848x848px · FOV: 45 degrees · NIDEK AFC-230 fundus camera · nonmydriatic · posterior pole color fundus photograph · diabetic retinopathy graded by the modified Davis classification:
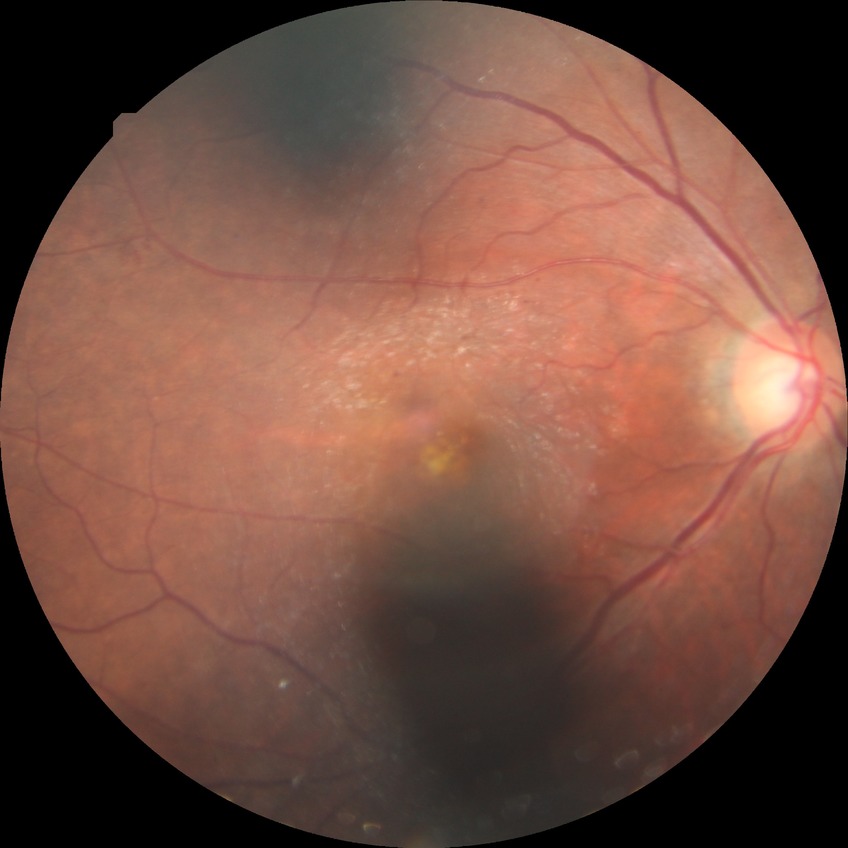 Diabetic retinopathy stage is simple diabetic retinopathy.